Fundus photo: 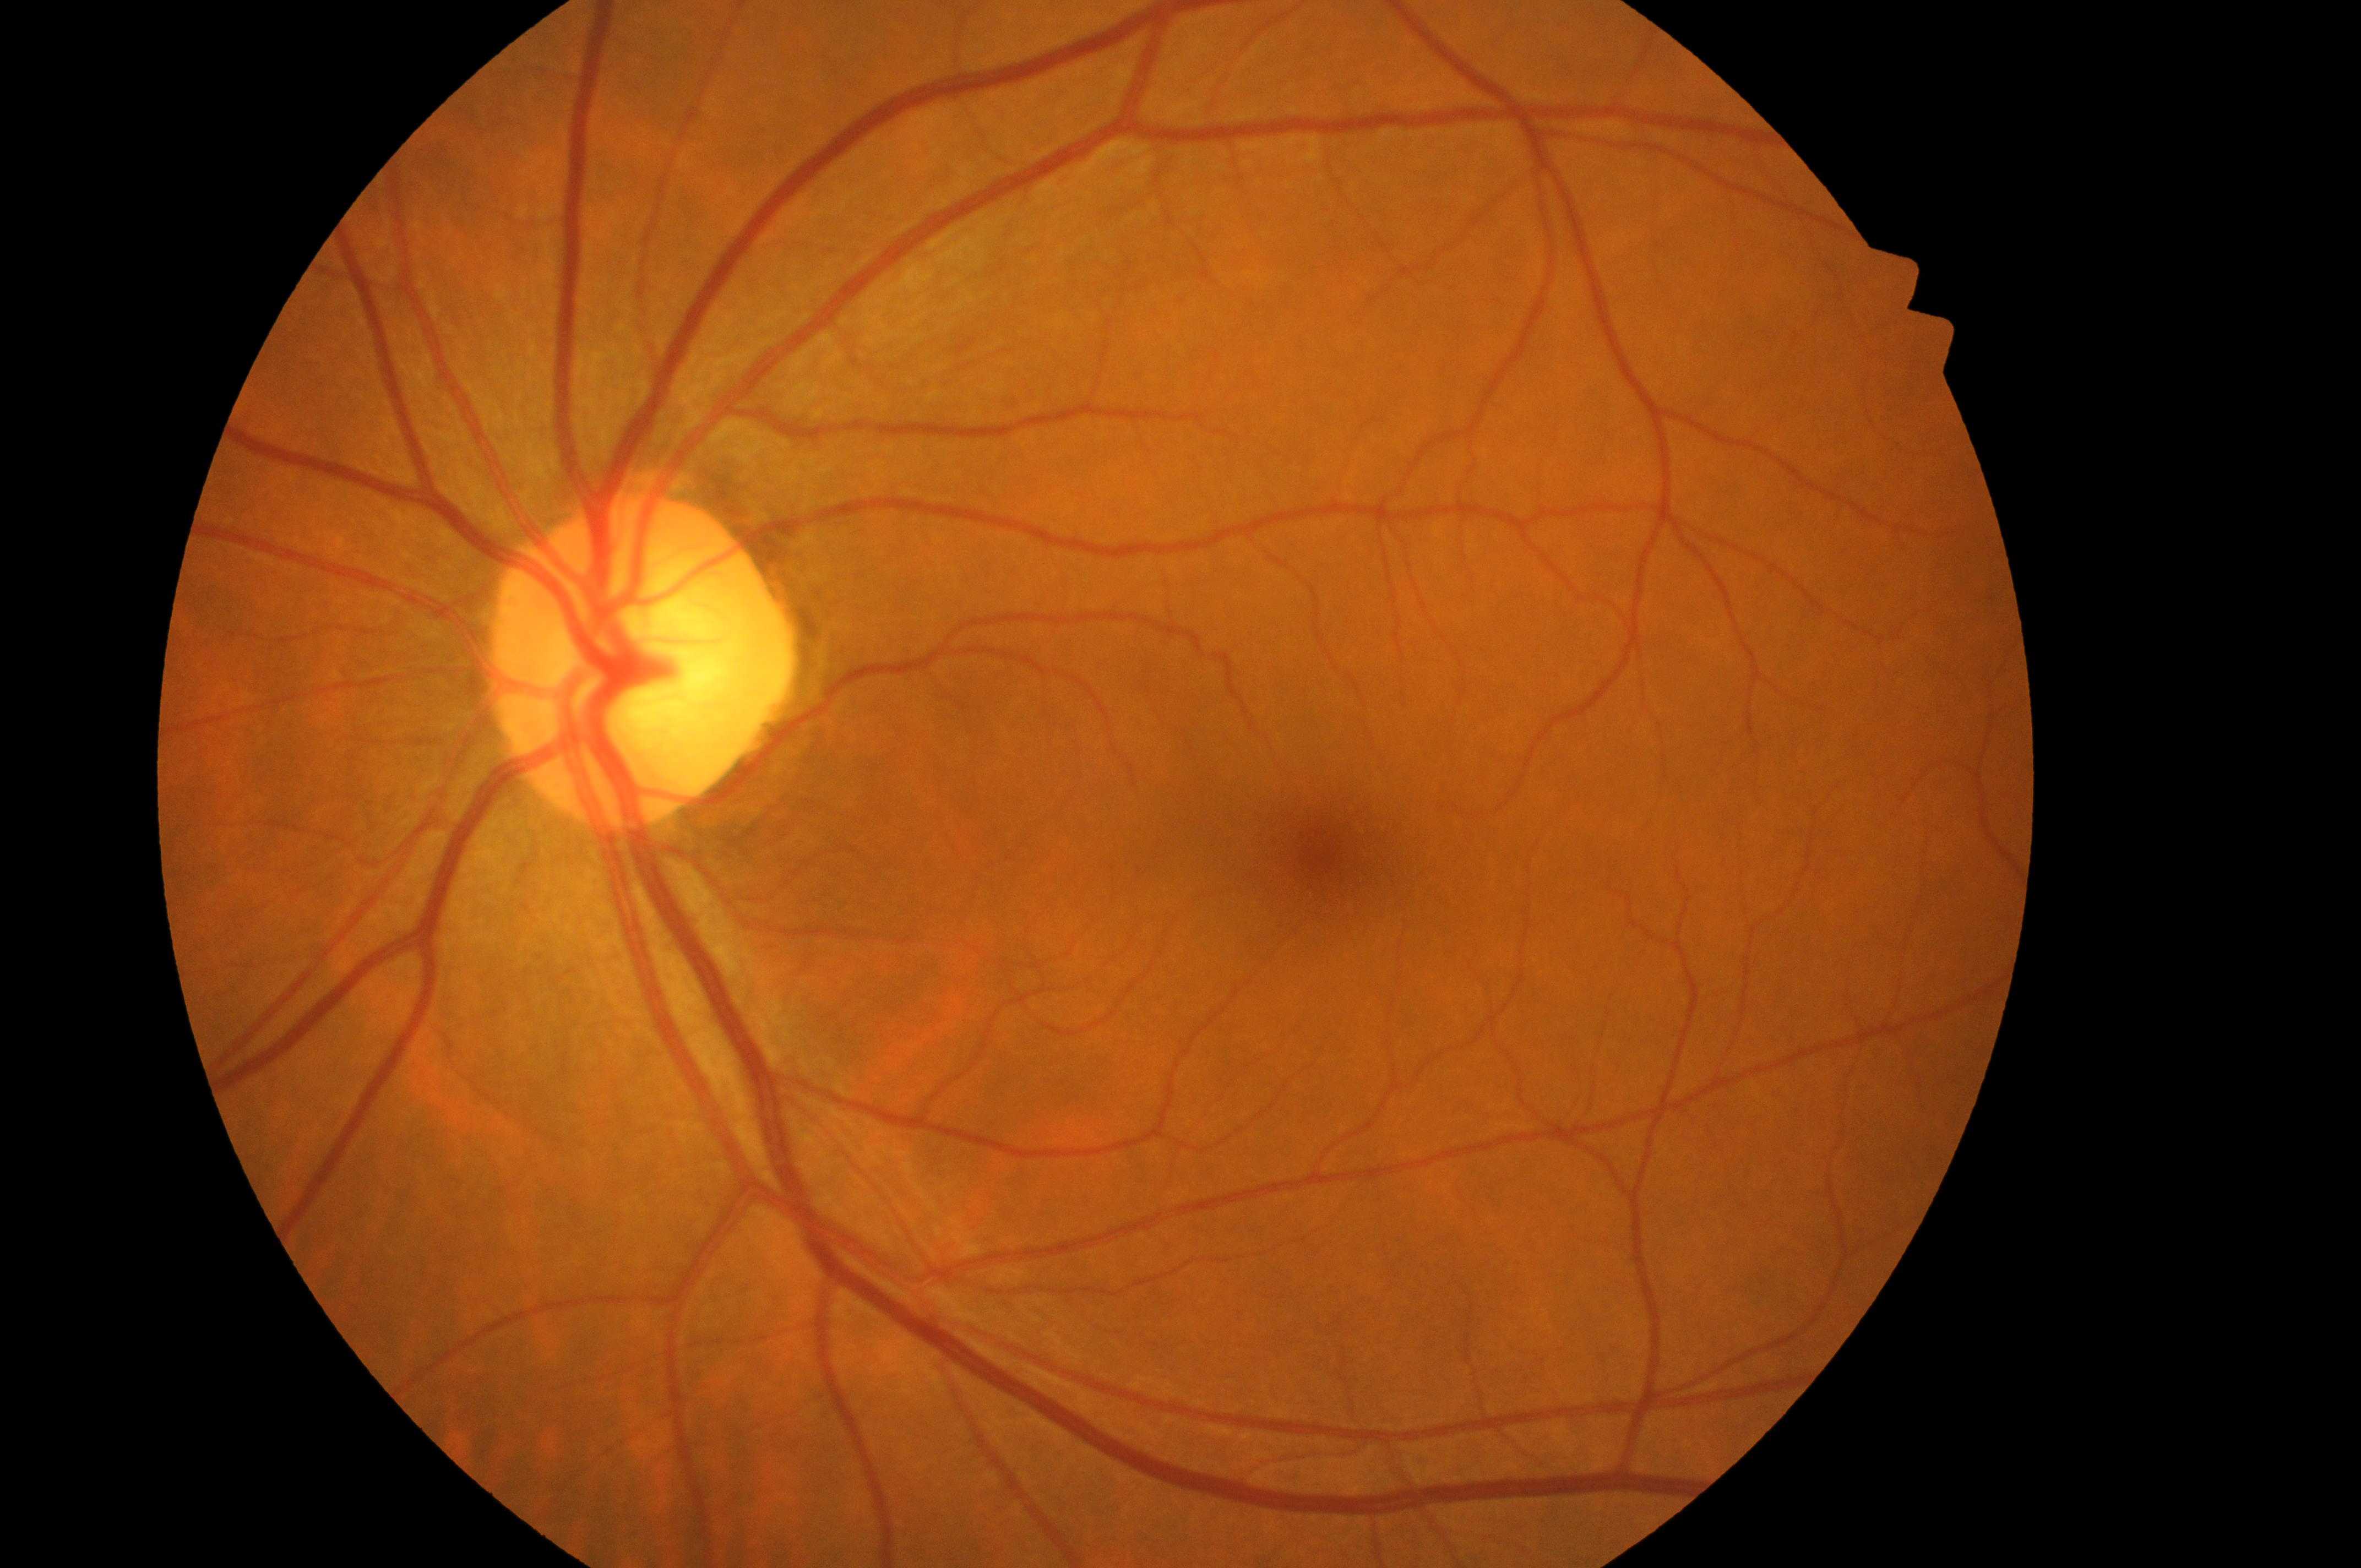
- DR impression: No apparent diabetic retinopathy or macular edema
- ONH: (x: 625, y: 668)
- eye: OS
- macula center: (x: 1324, y: 856)
- DR grade: 0/4
- DME: grade 0